45° field of view
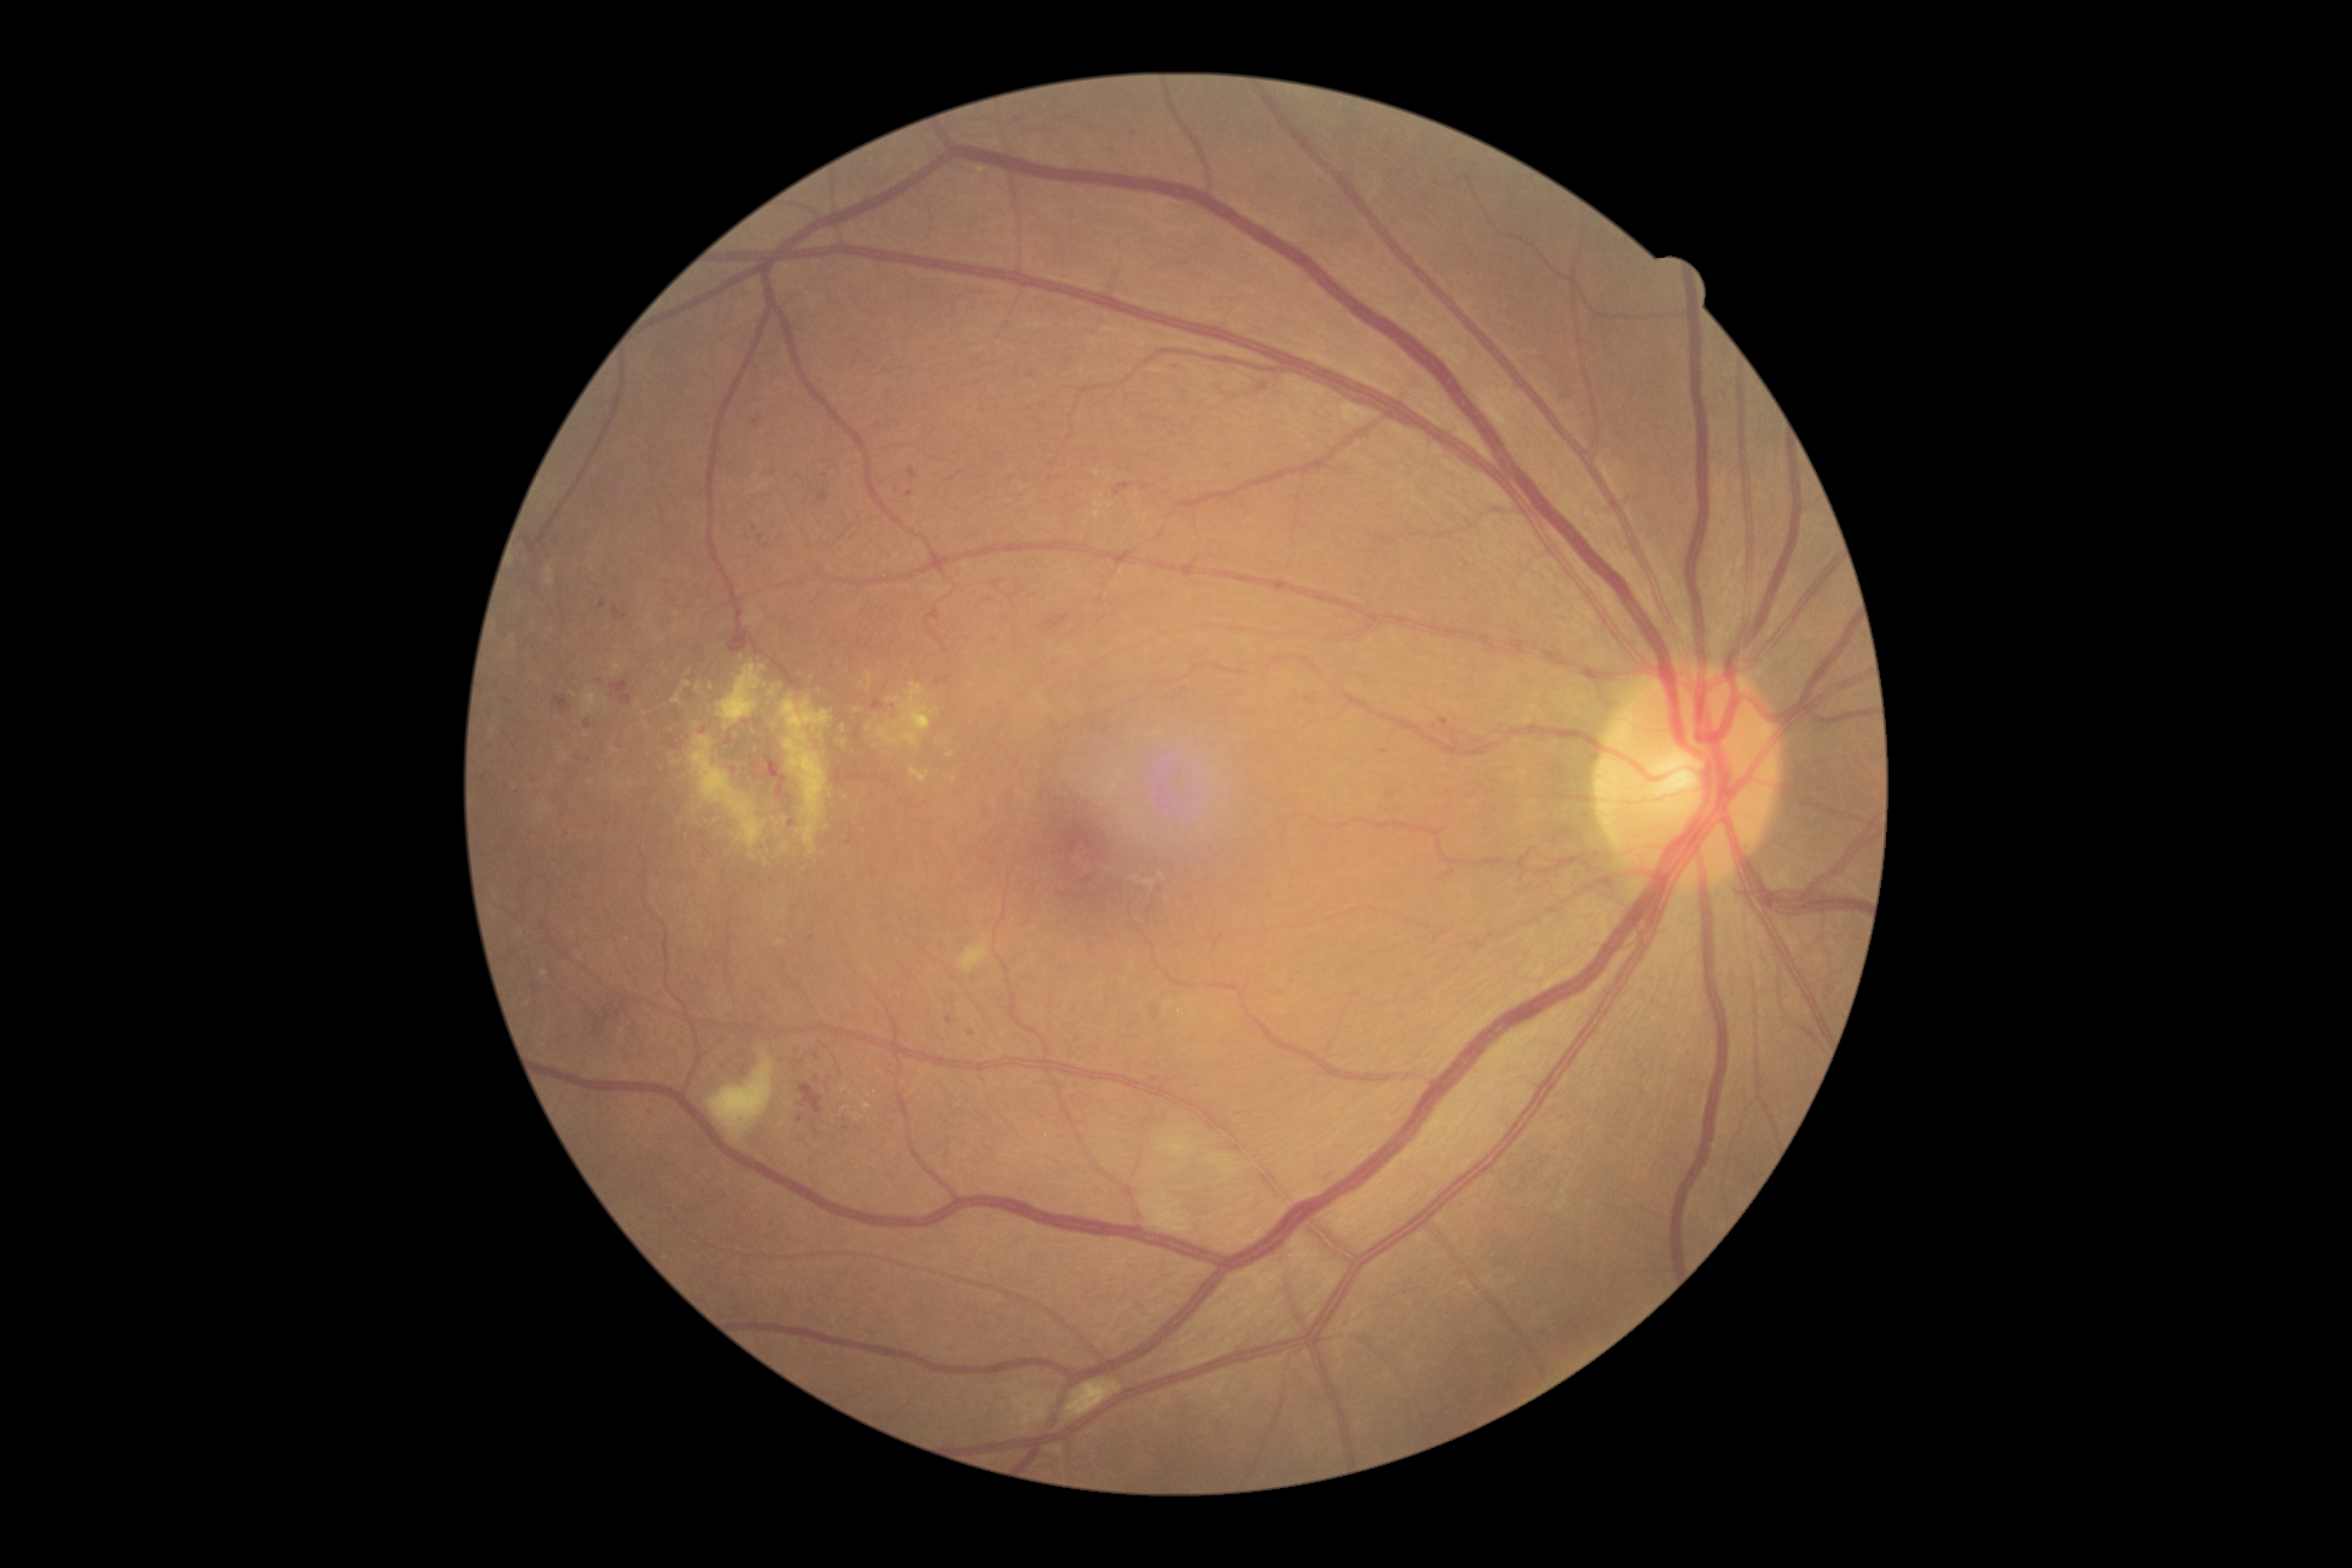 Diabetic retinopathy (DR): severe non-proliferative diabetic retinopathy (grade 3). Microaneurysms (MAs) include BBox(848, 835, 852, 845); BBox(946, 1016, 953, 1025); BBox(817, 492, 829, 501); BBox(757, 534, 765, 541); BBox(725, 737, 731, 745); BBox(908, 469, 916, 480); BBox(1083, 878, 1091, 884). Small MAs approximately at 791/823; 878/426; 1180/369; 971/1032; 754/529; 734/770; 790/798; 652/1112; 817/1057; 745/722; 580/760; 1154/1078. Hard exudates (EXs) include BBox(683, 682, 691, 687); BBox(861, 1098, 872, 1111); BBox(716, 664, 766, 730); BBox(782, 843, 787, 852); BBox(690, 736, 766, 849); BBox(850, 1111, 862, 1121); BBox(909, 766, 930, 783); BBox(750, 852, 758, 860); BBox(887, 696, 900, 702). Small EXs approximately at 711/687; 845/743; 875/1092; 869/1095; 953/779; 858/710; 766/685; 843/727.